1932x1916 · 45° FOV · fundus photo:
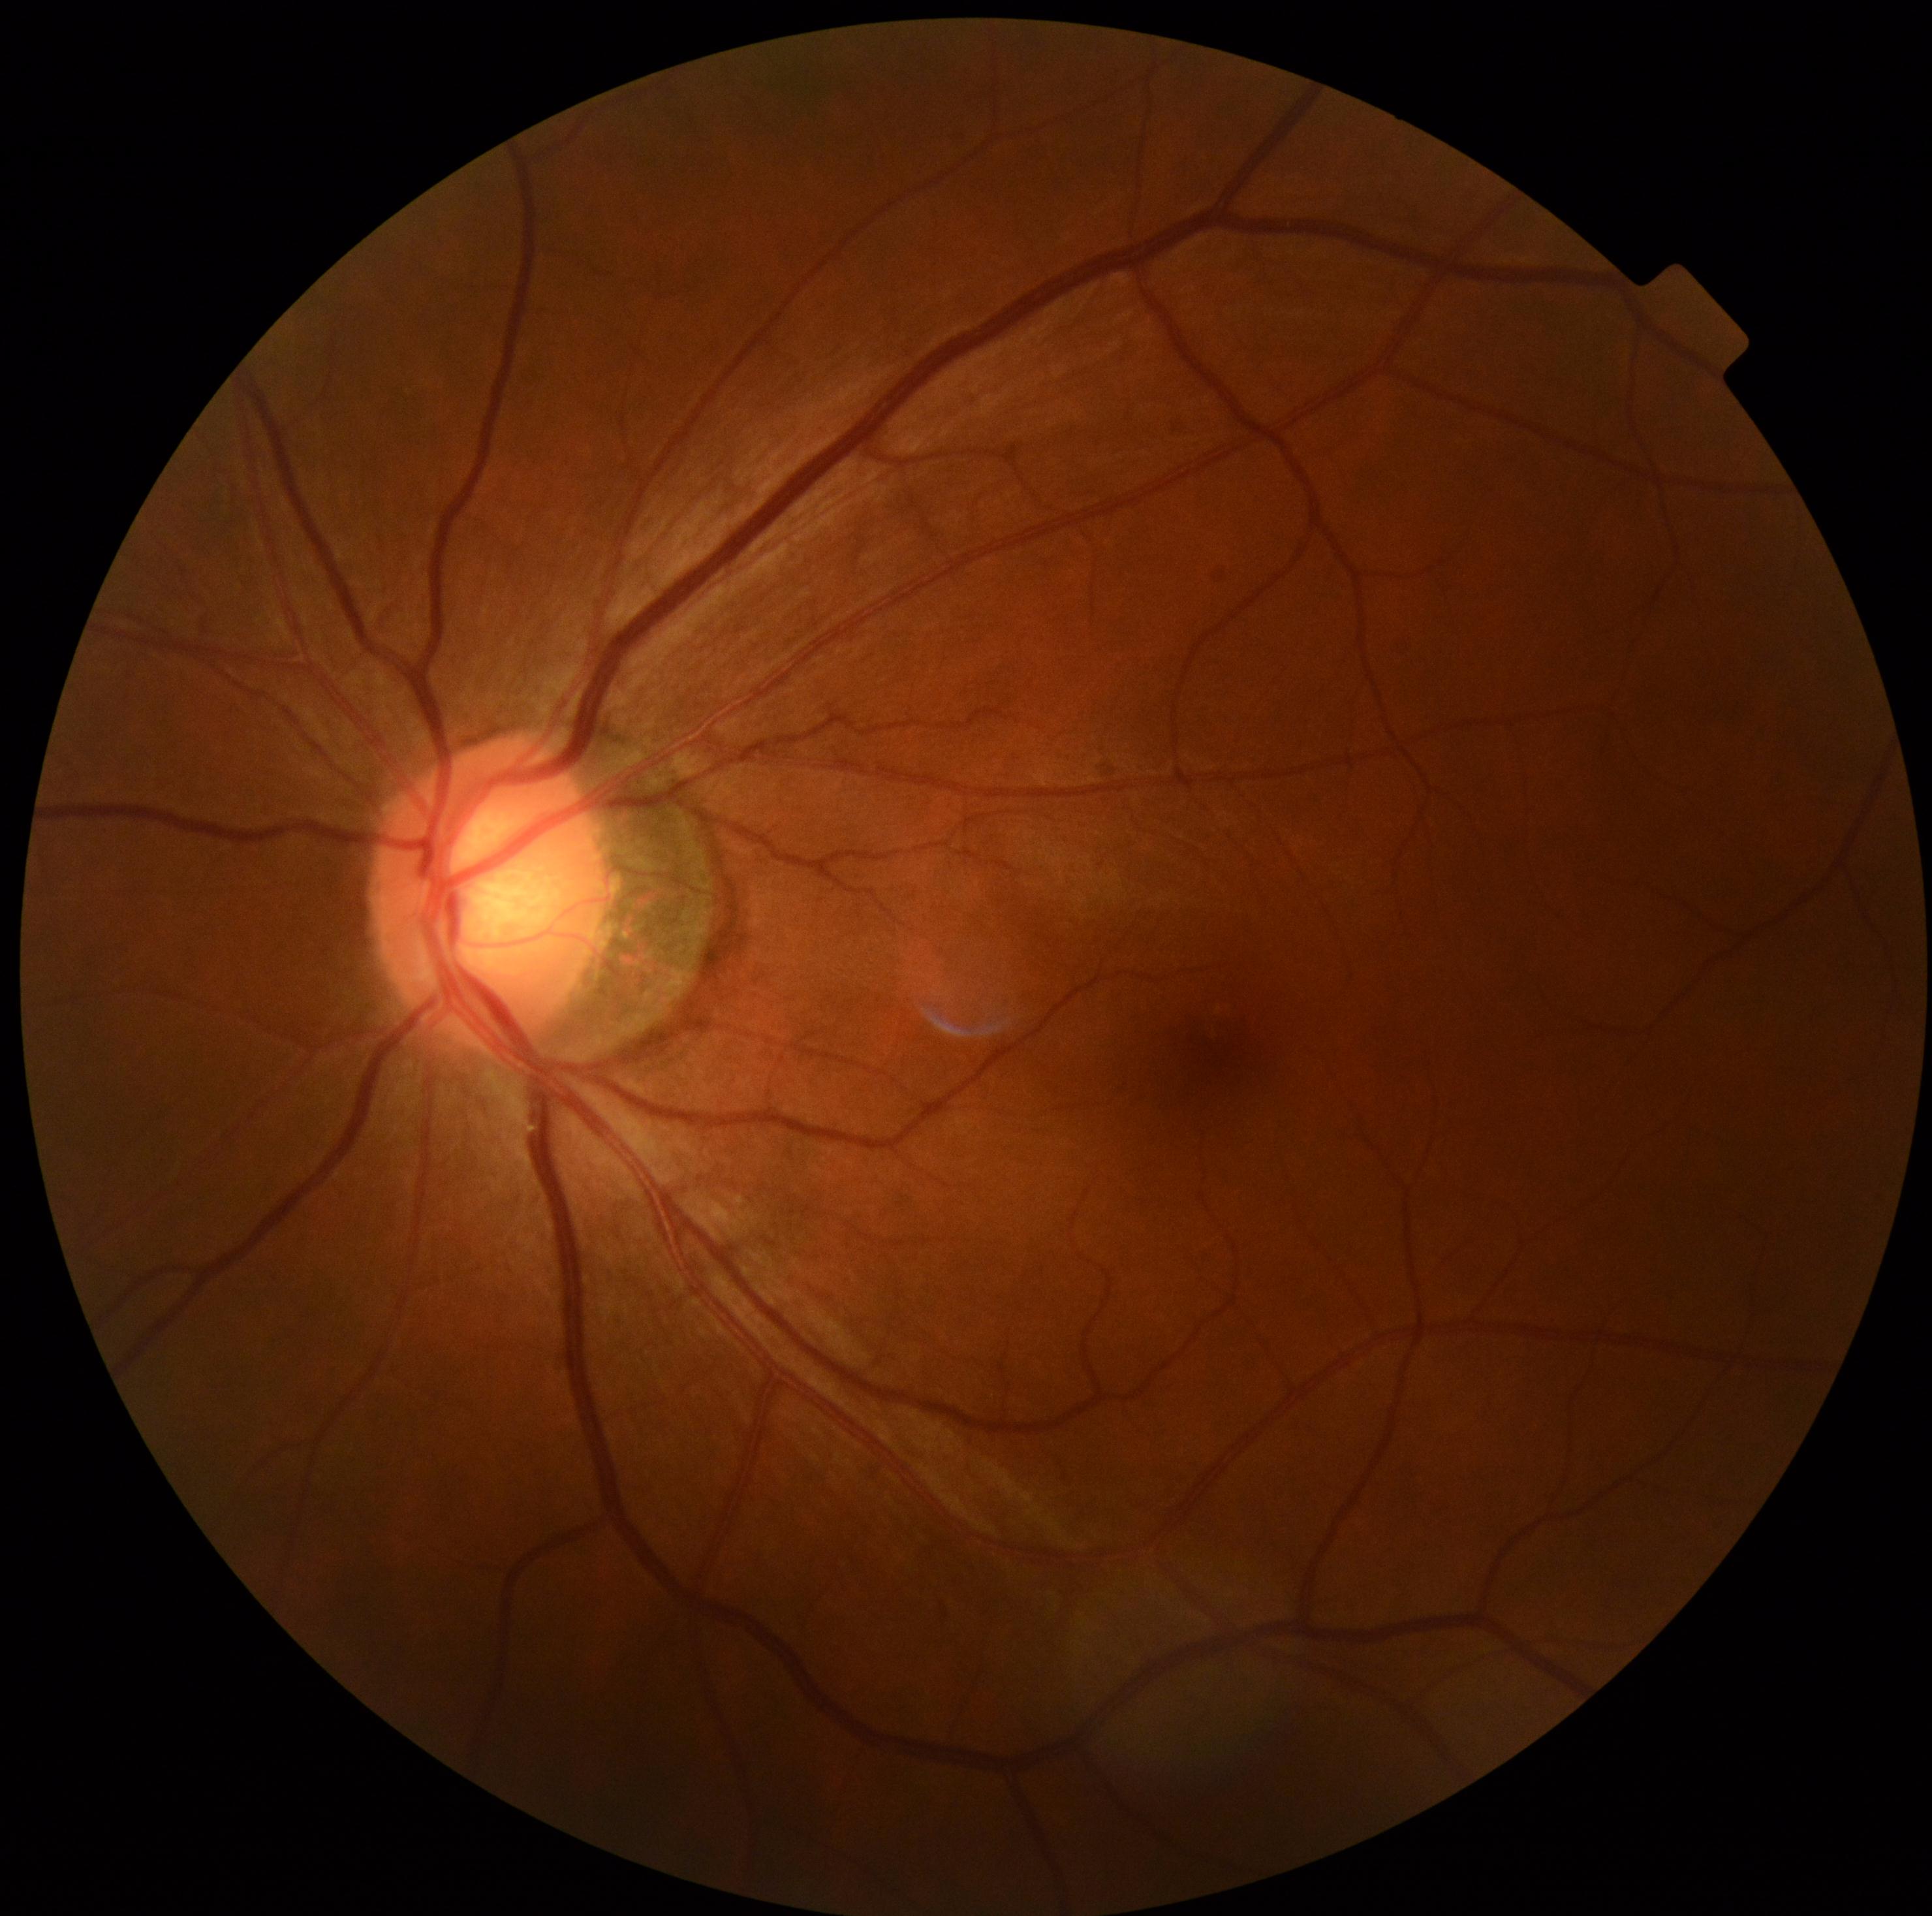

No apparent diabetic retinopathy.
DR stage: no apparent diabetic retinopathy (grade 0).